2352 x 1568 pixels. 45-degree field of view. Retinal fundus photograph:
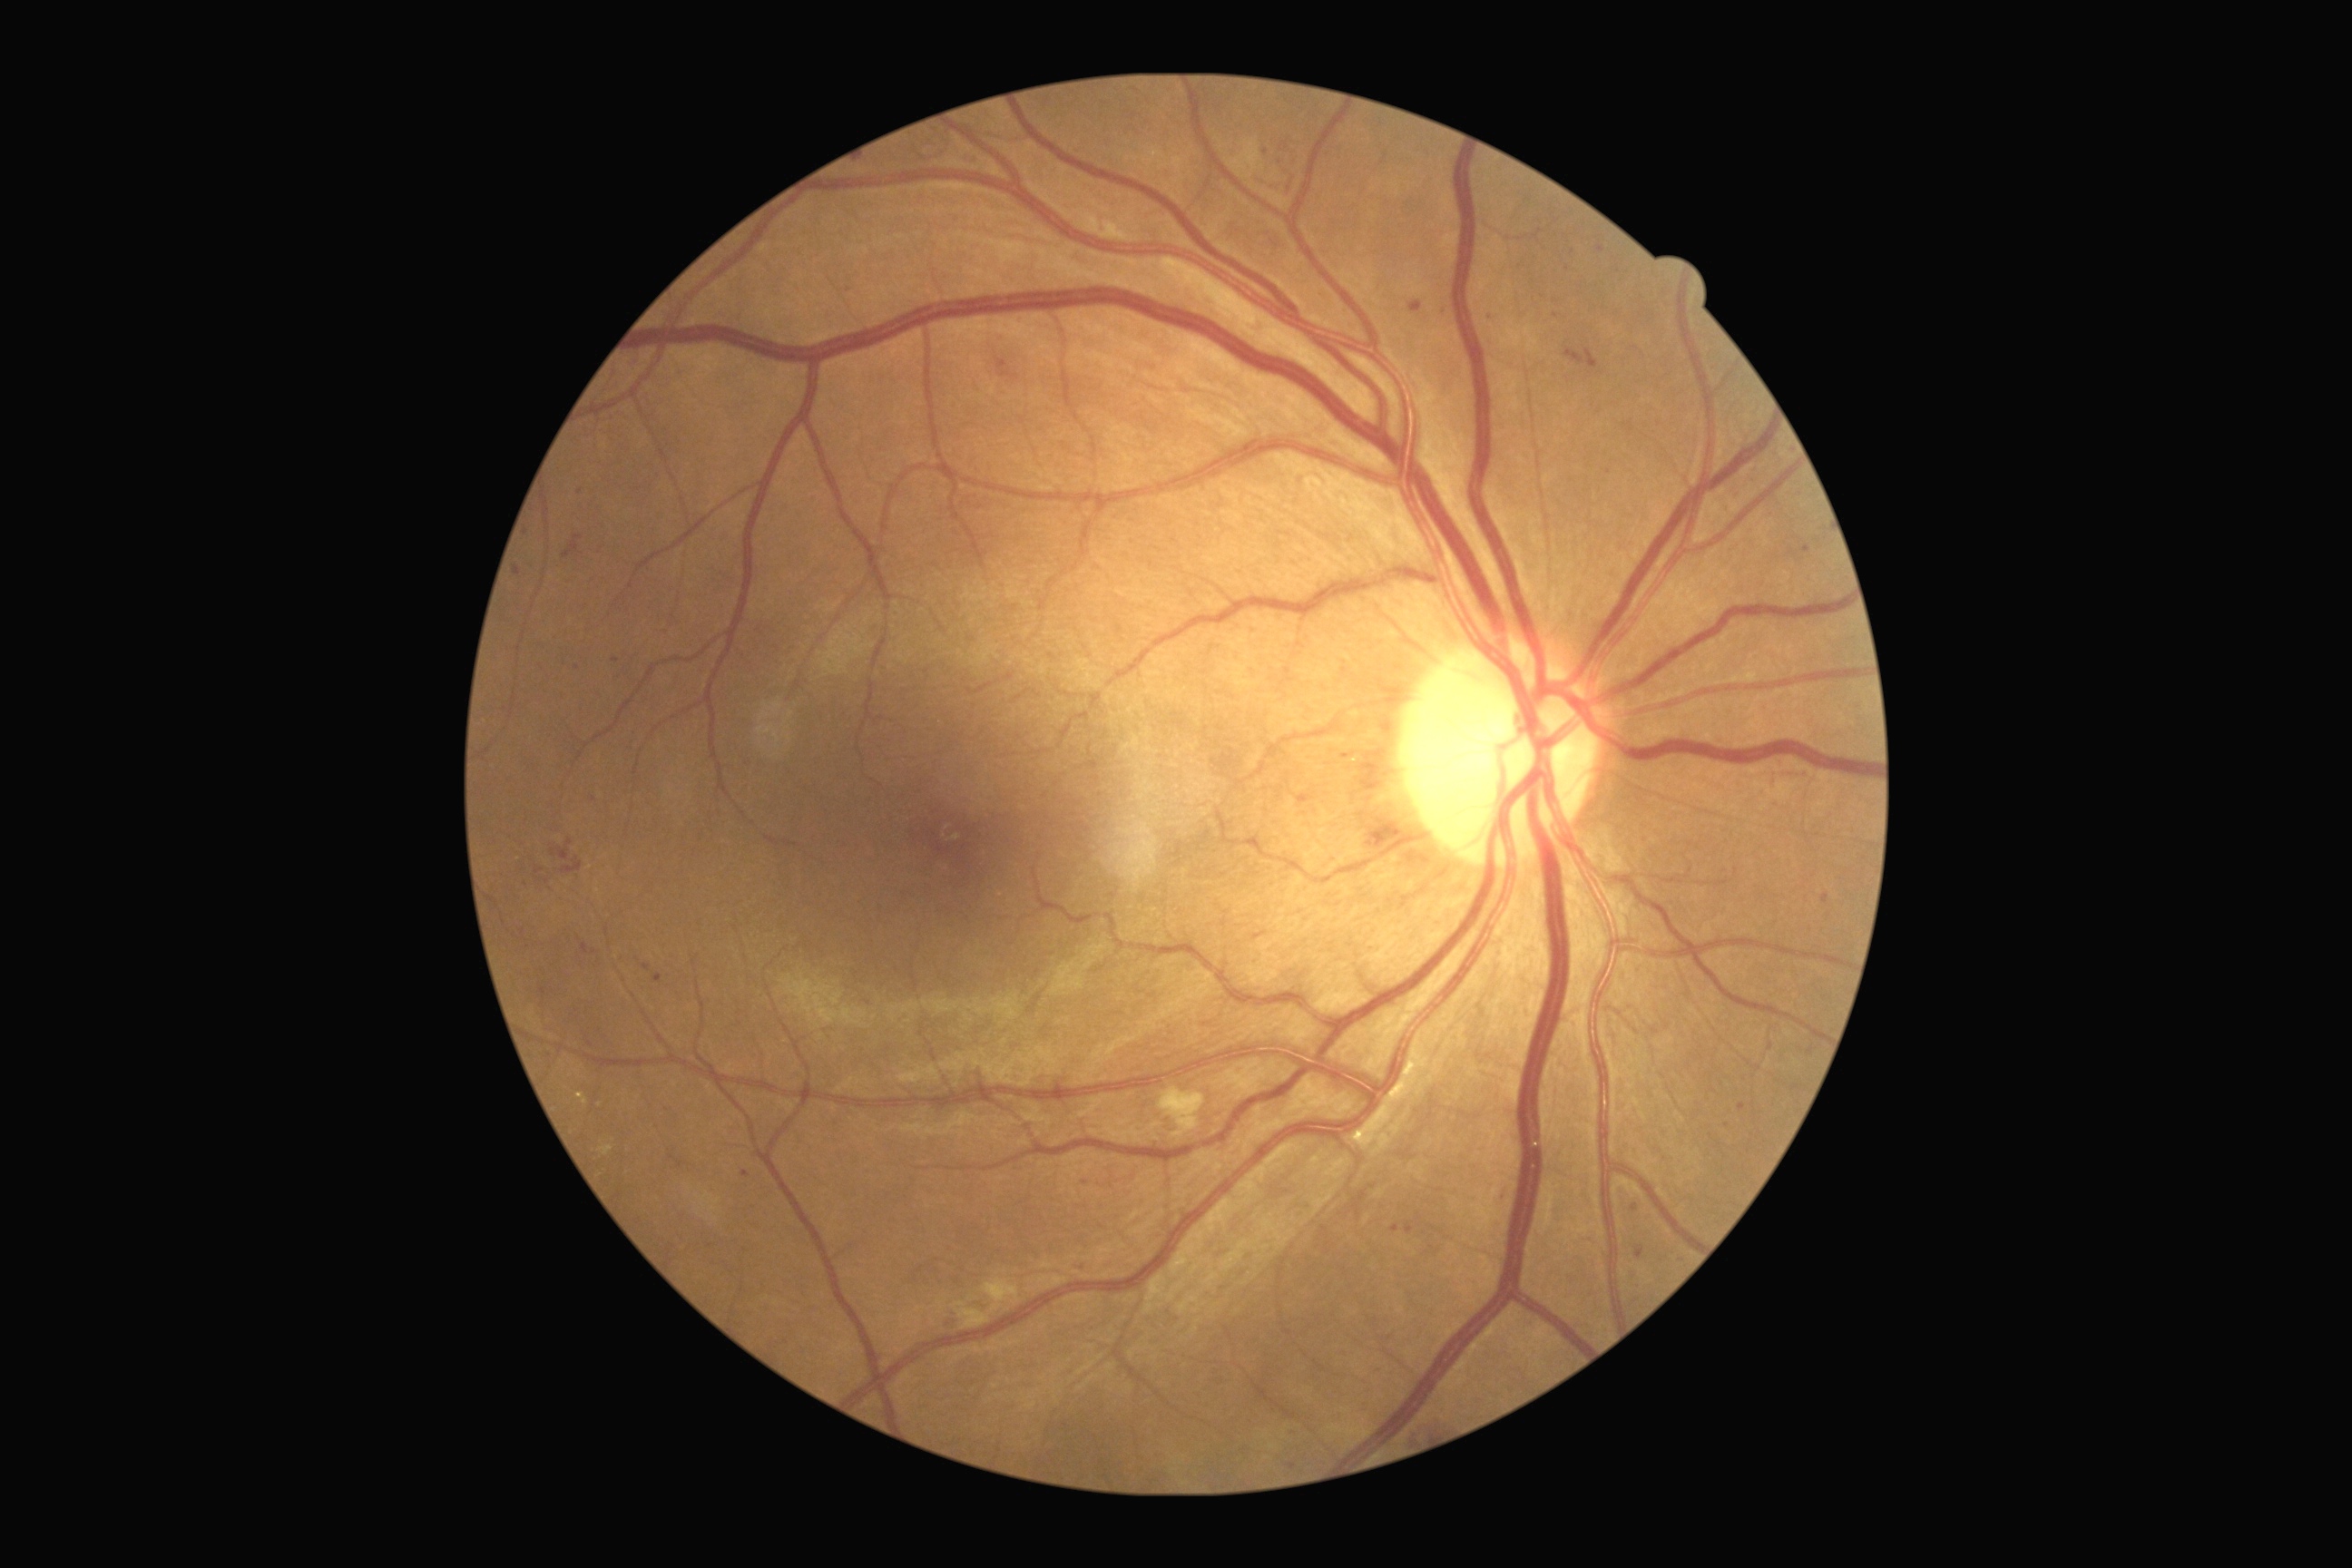

DR grade is 2.